Without pupil dilation.
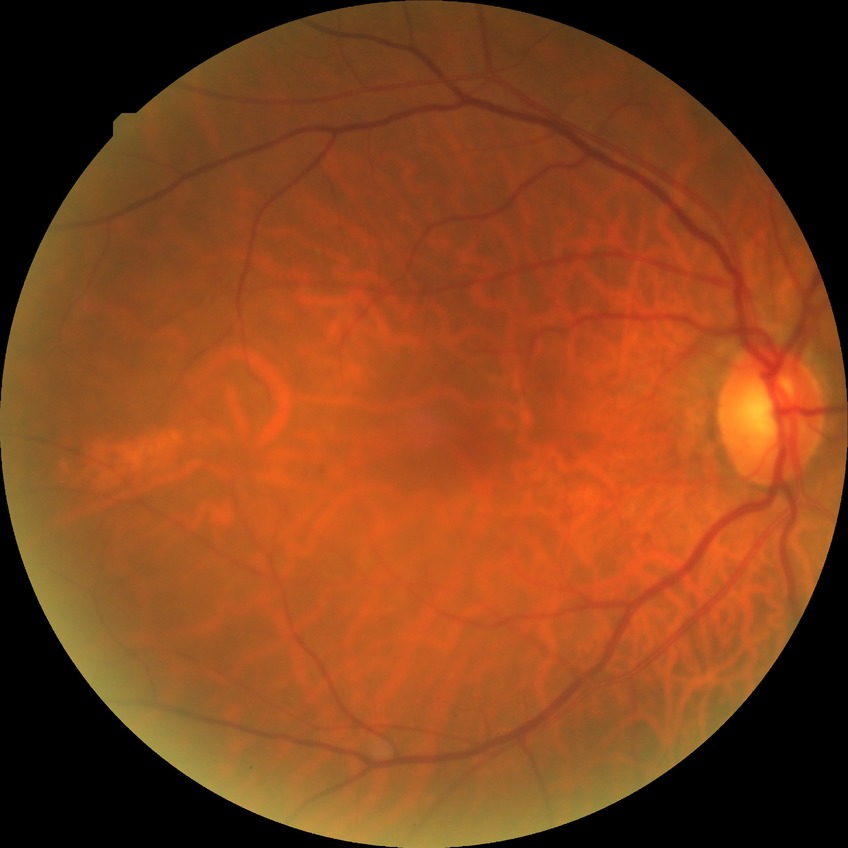
diabetic retinopathy (DR): SDR (simple diabetic retinopathy).